Infant wide-field retinal image
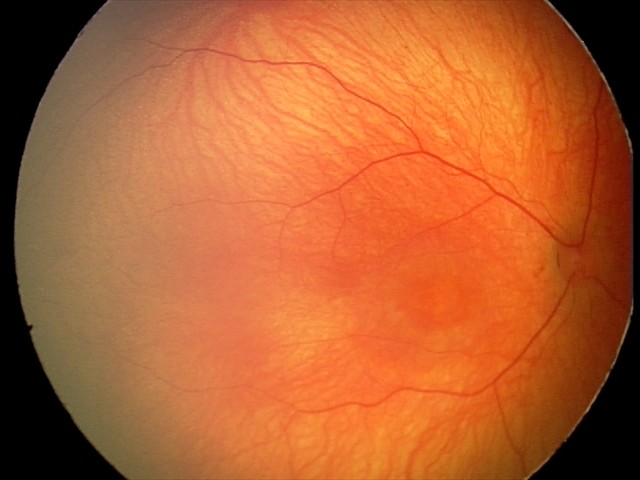
Finding: no abnormalities